45° FOV — 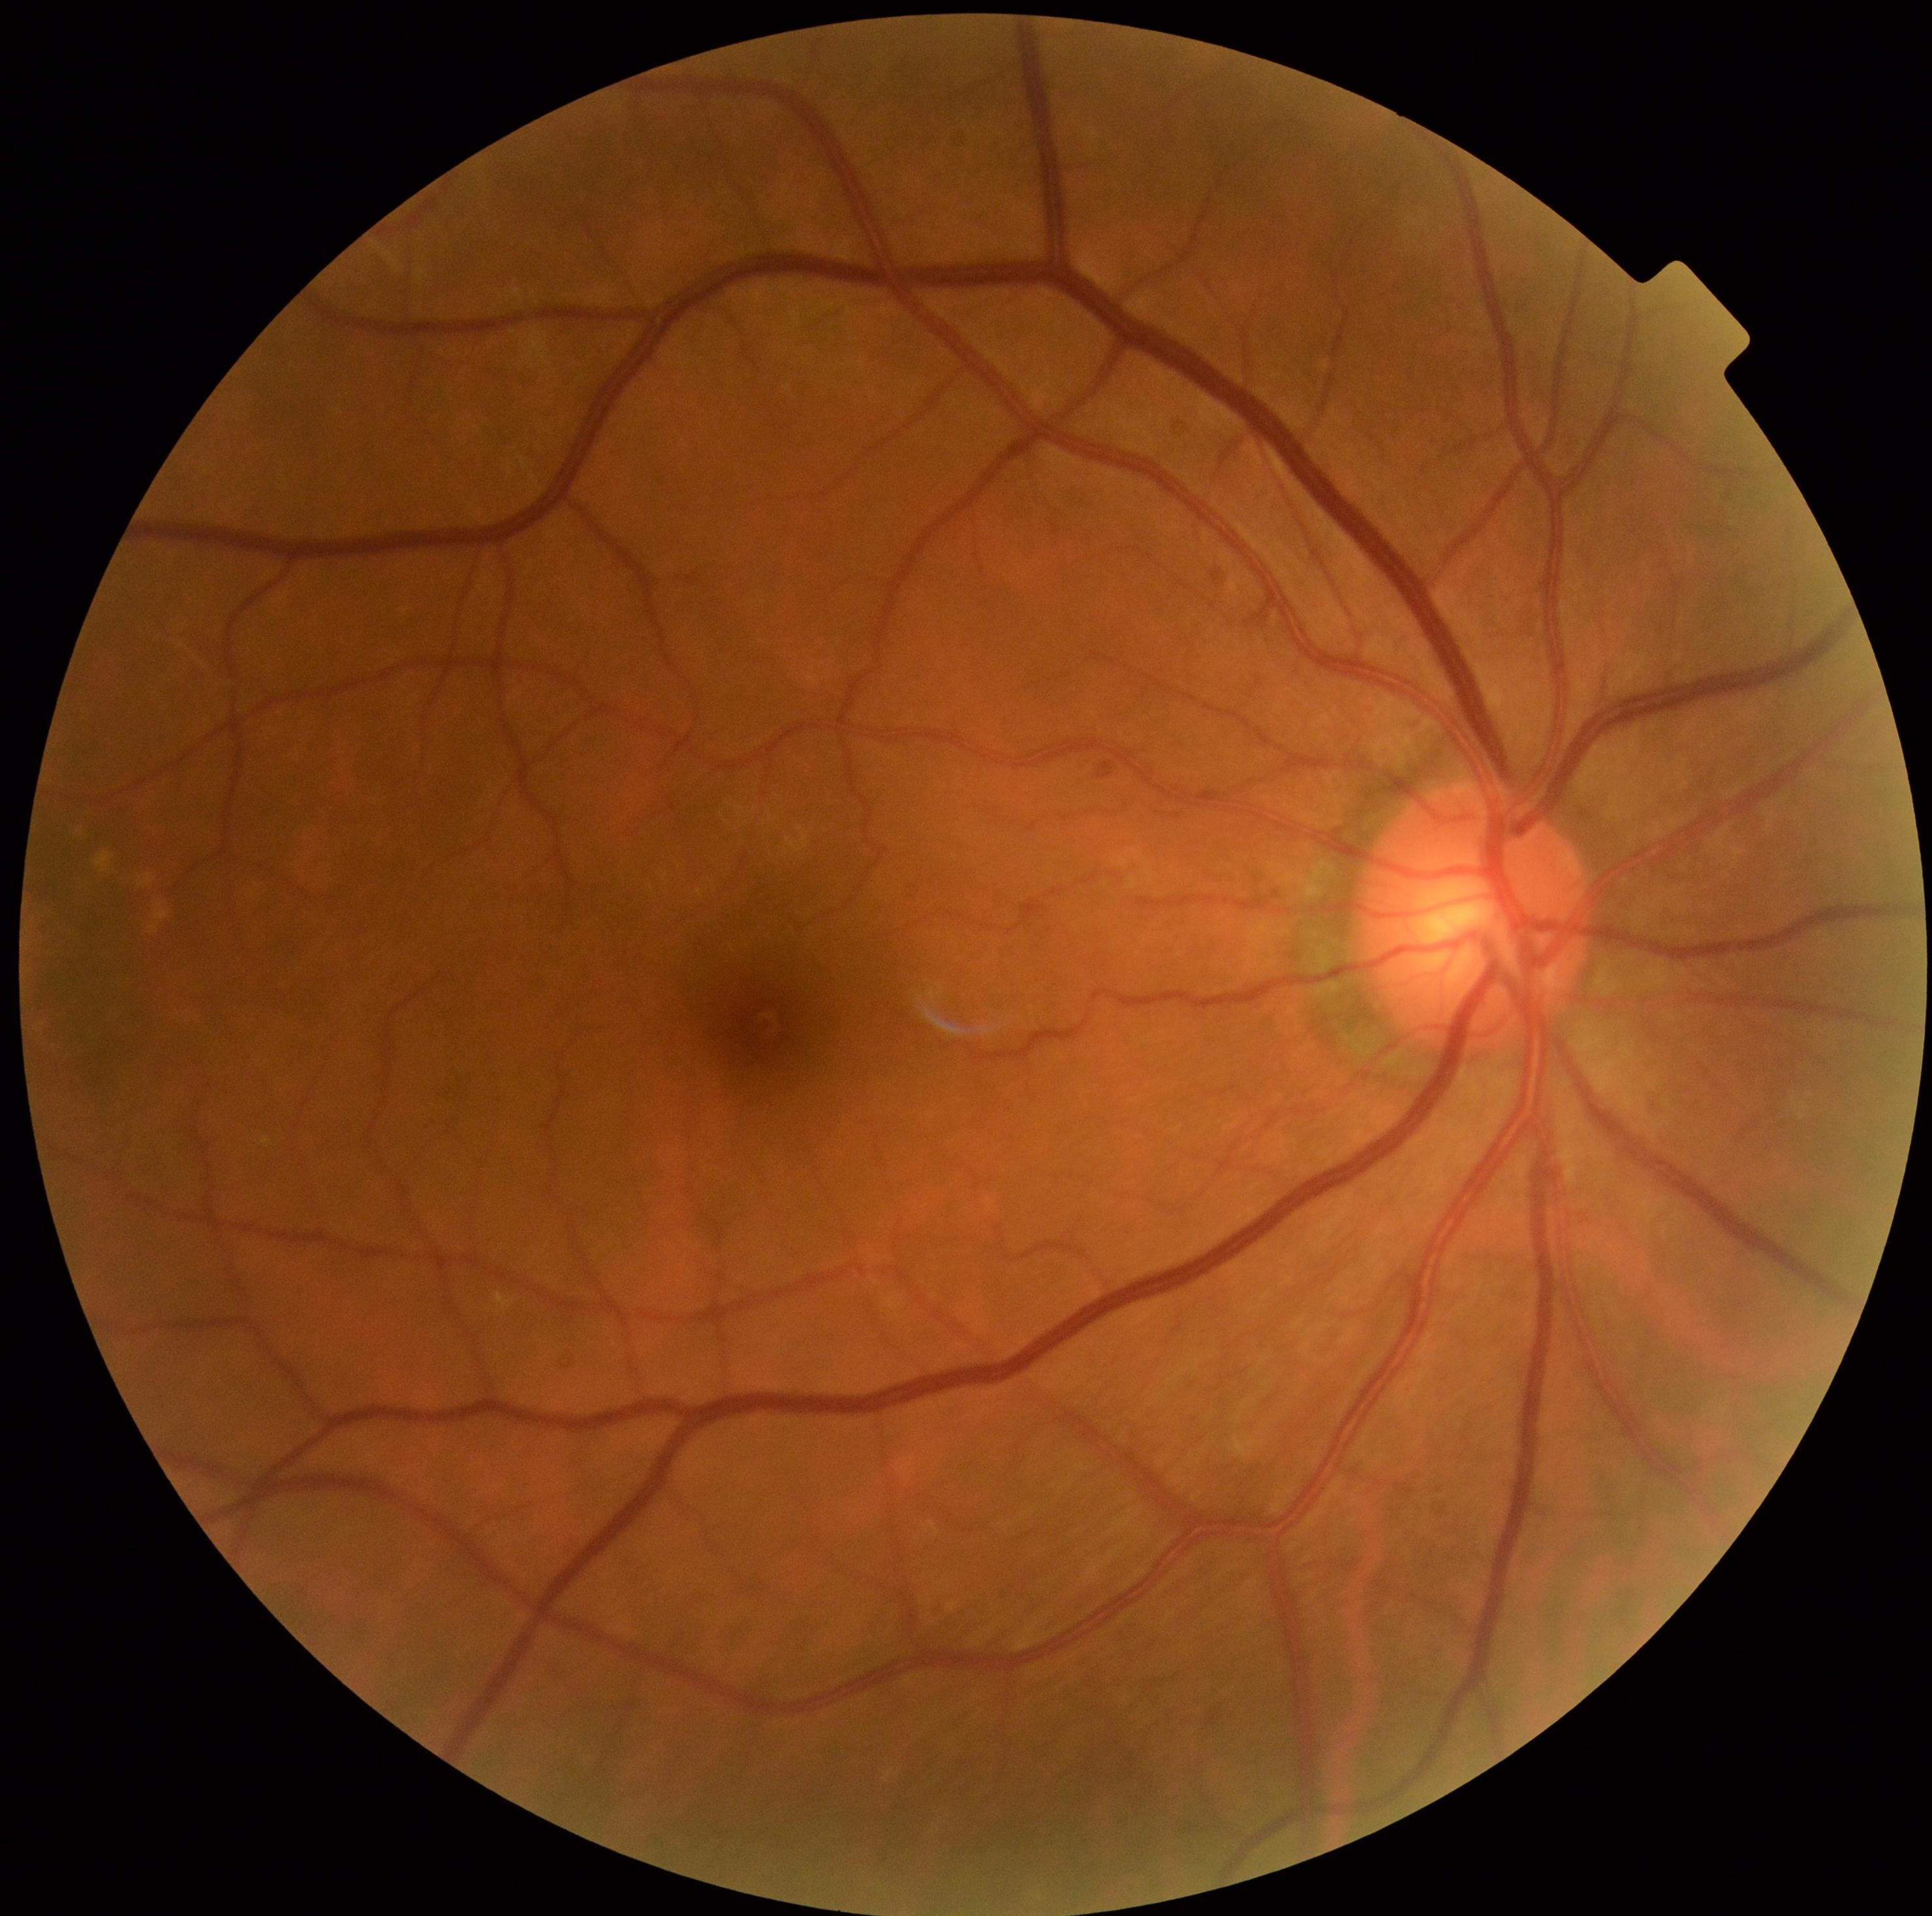

Diabetic retinopathy (DR): 0/4.